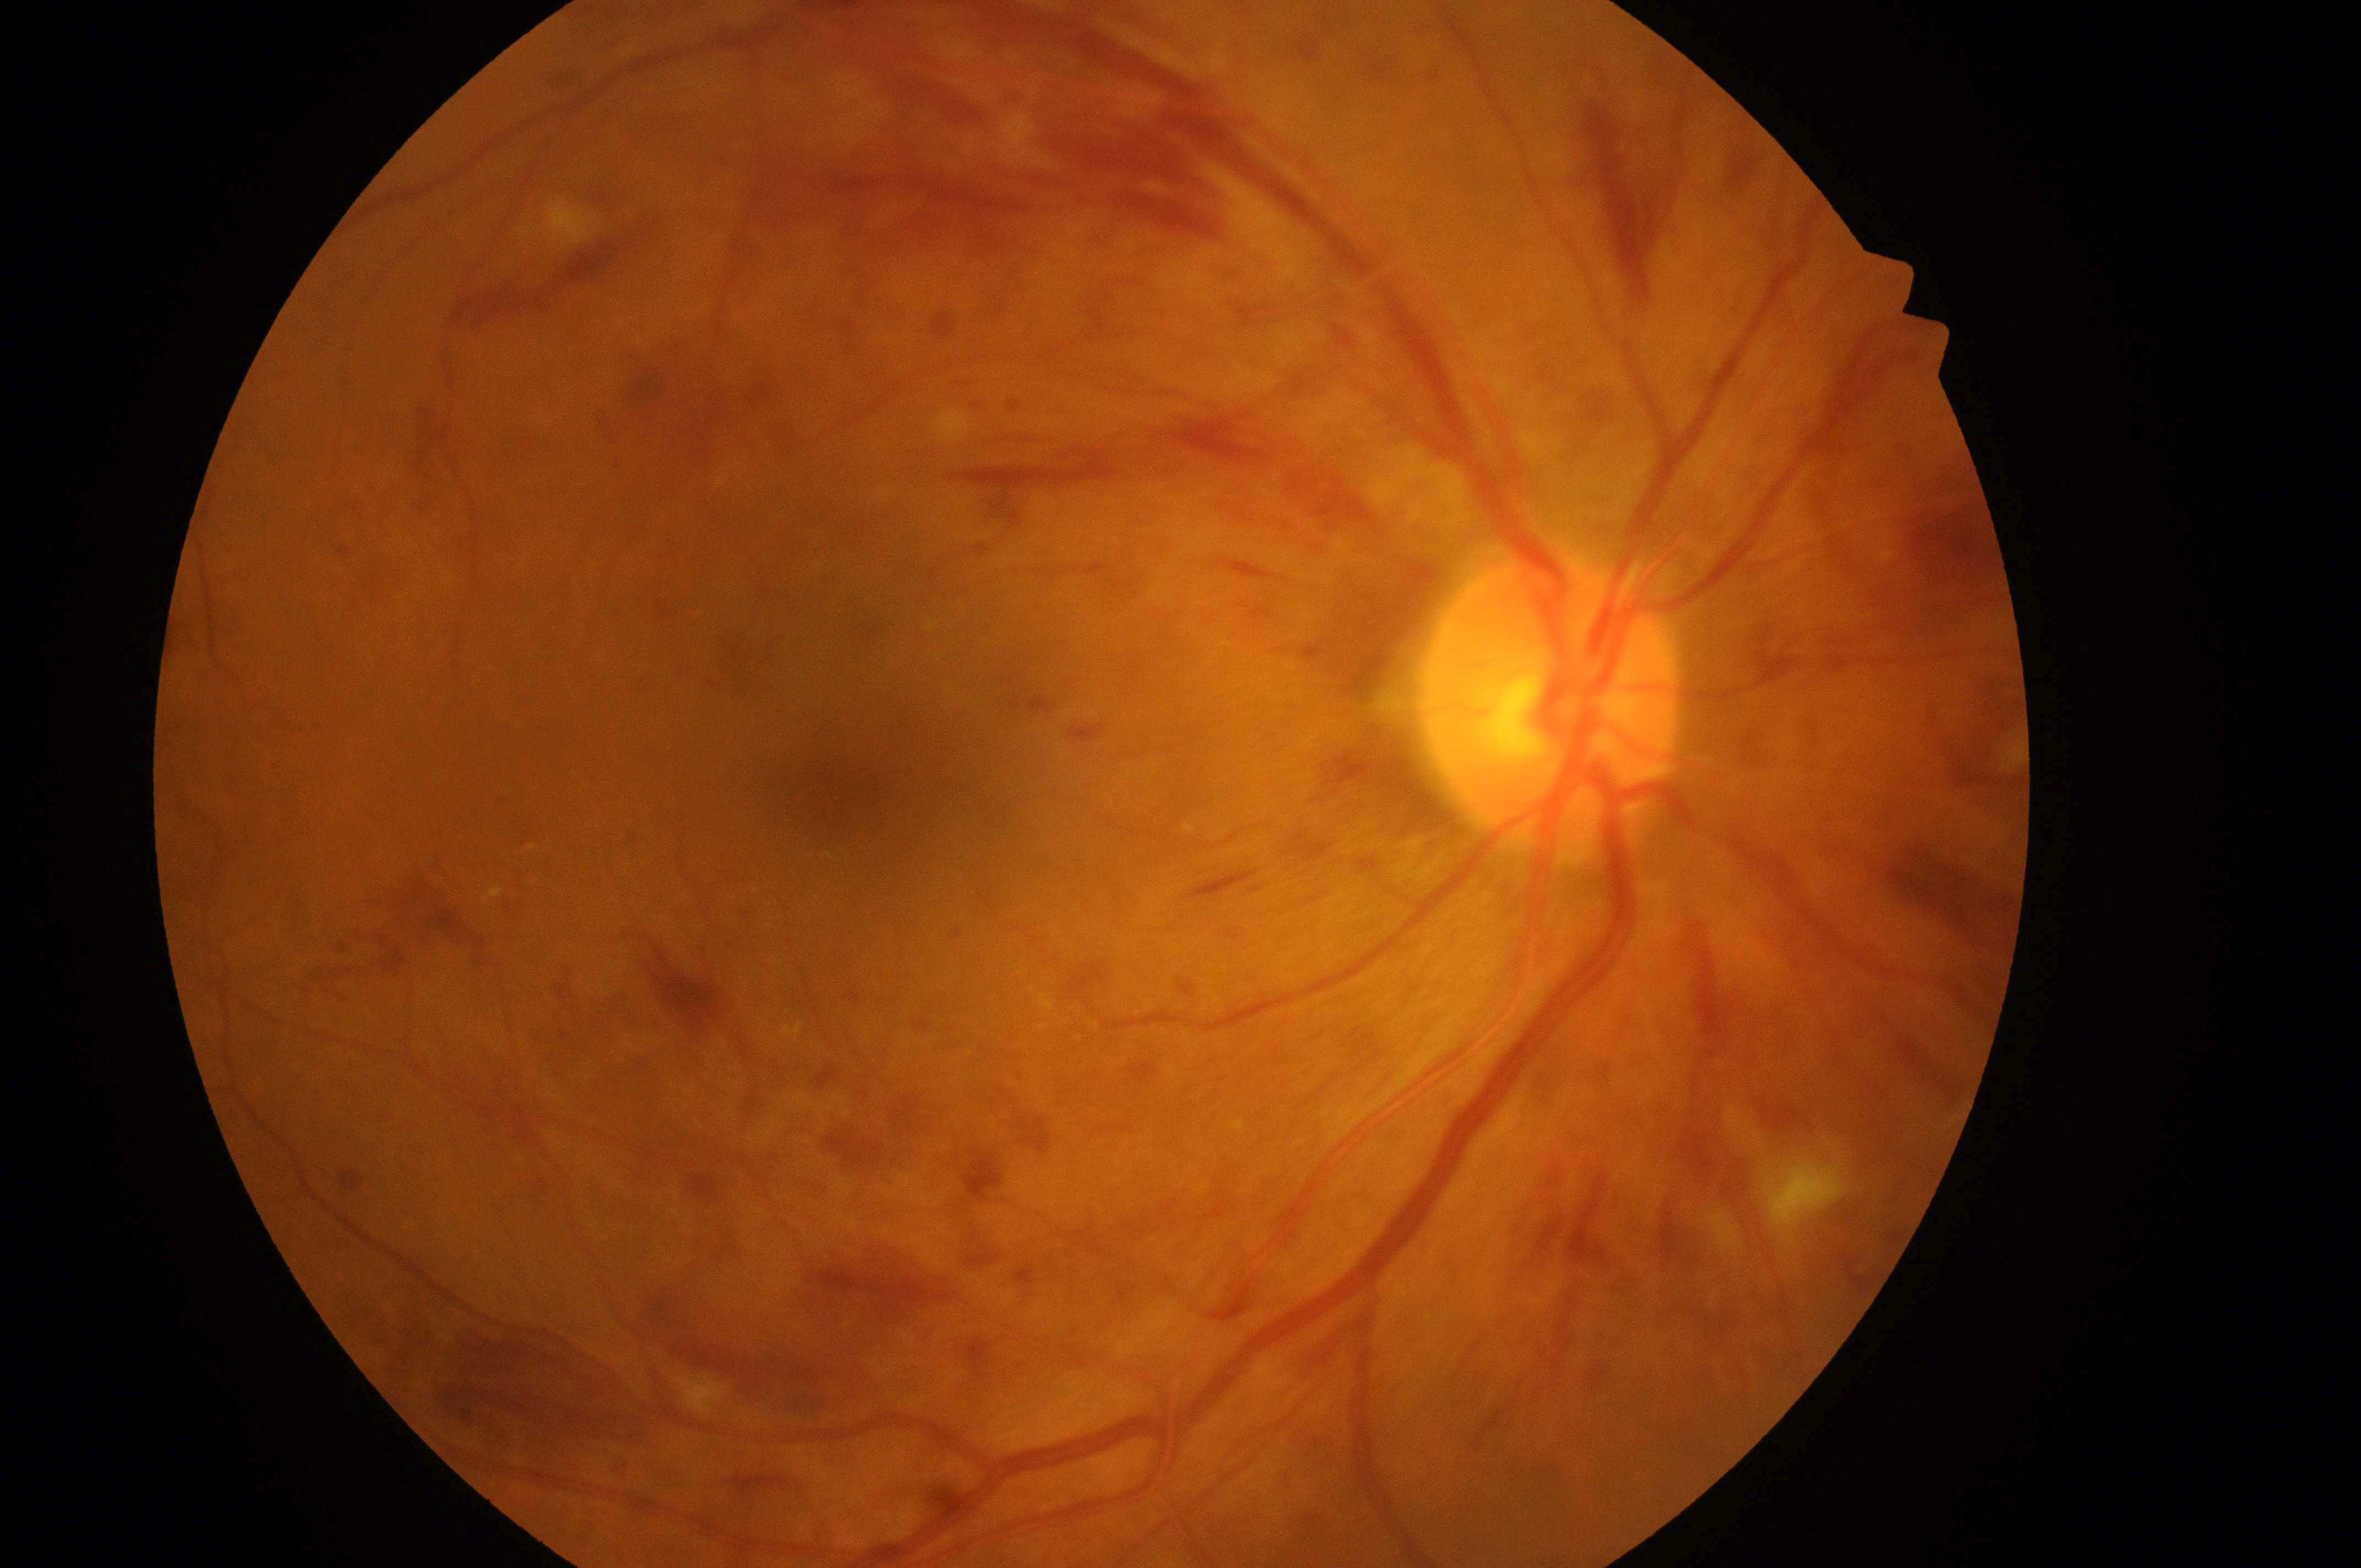 Diabetic macular edema is grade 2.
Optic nerve head located at 1545px, 713px.
The image shows the oculus dexter.
Diabetic retinopathy: grade 3.
The macula center is at 852px, 798px.